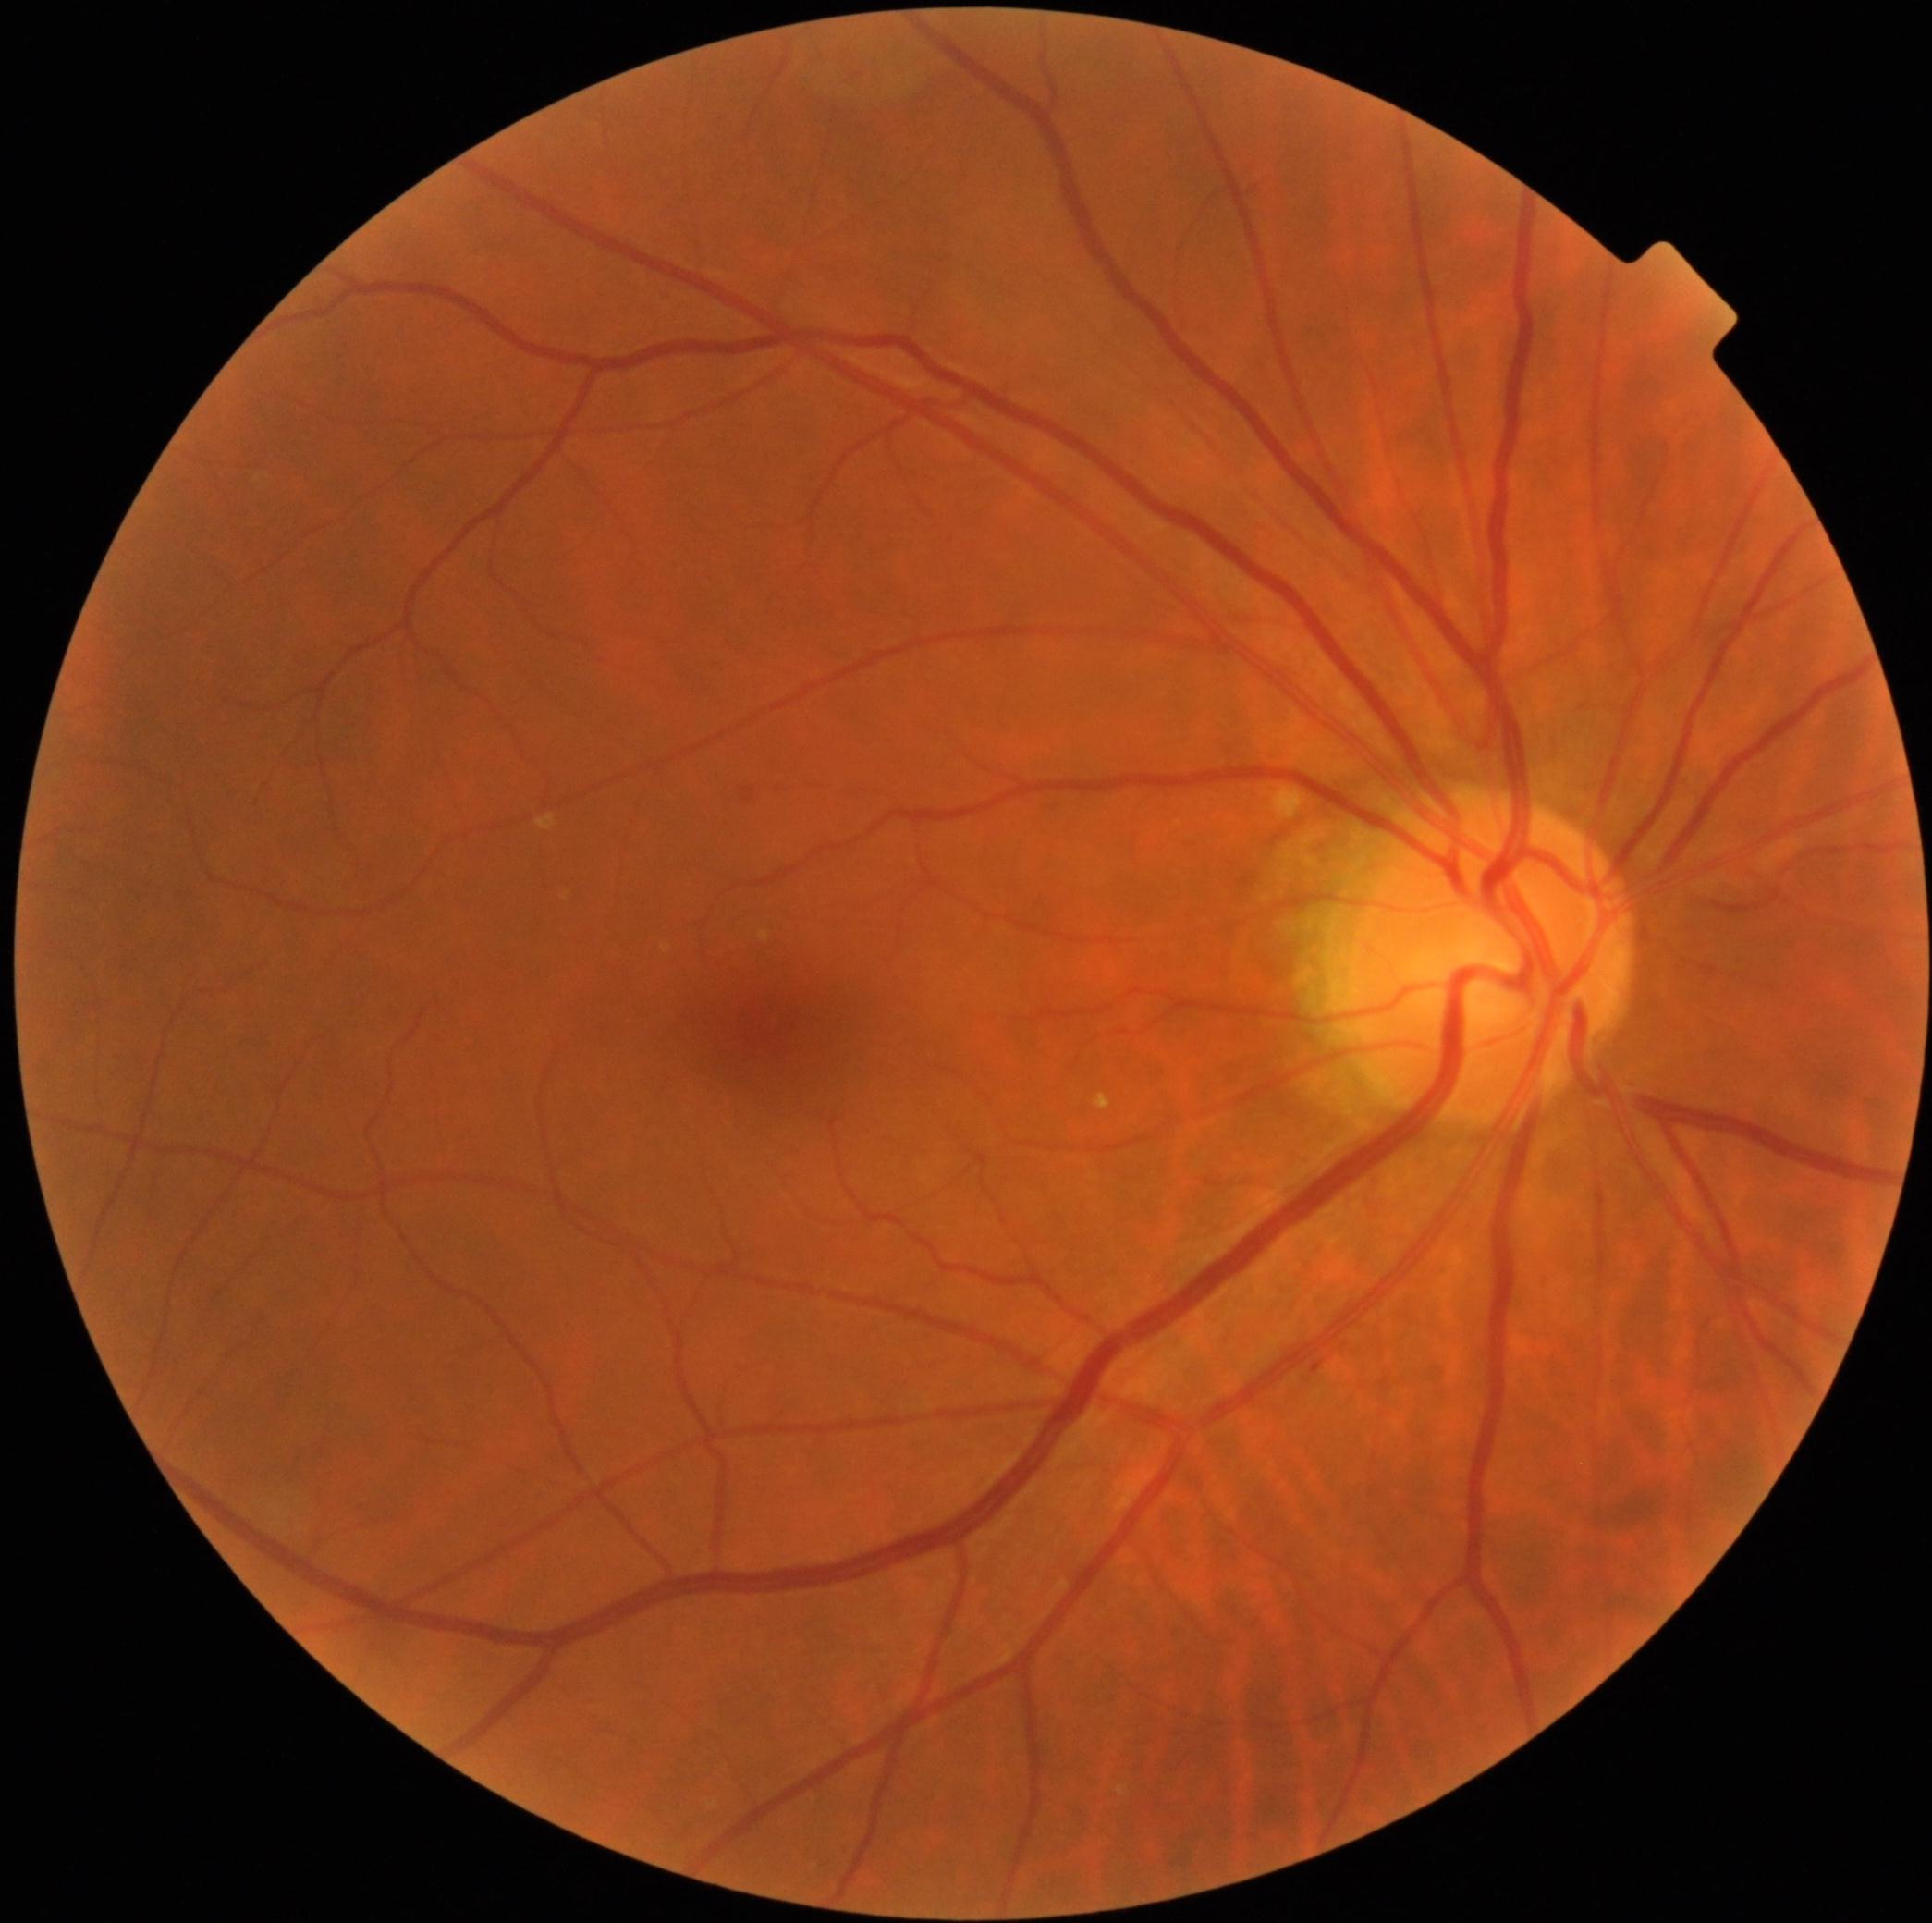
diabetic retinopathy (DR): grade 0 | DR impression: no signs of DR.